2352 by 1568 pixels
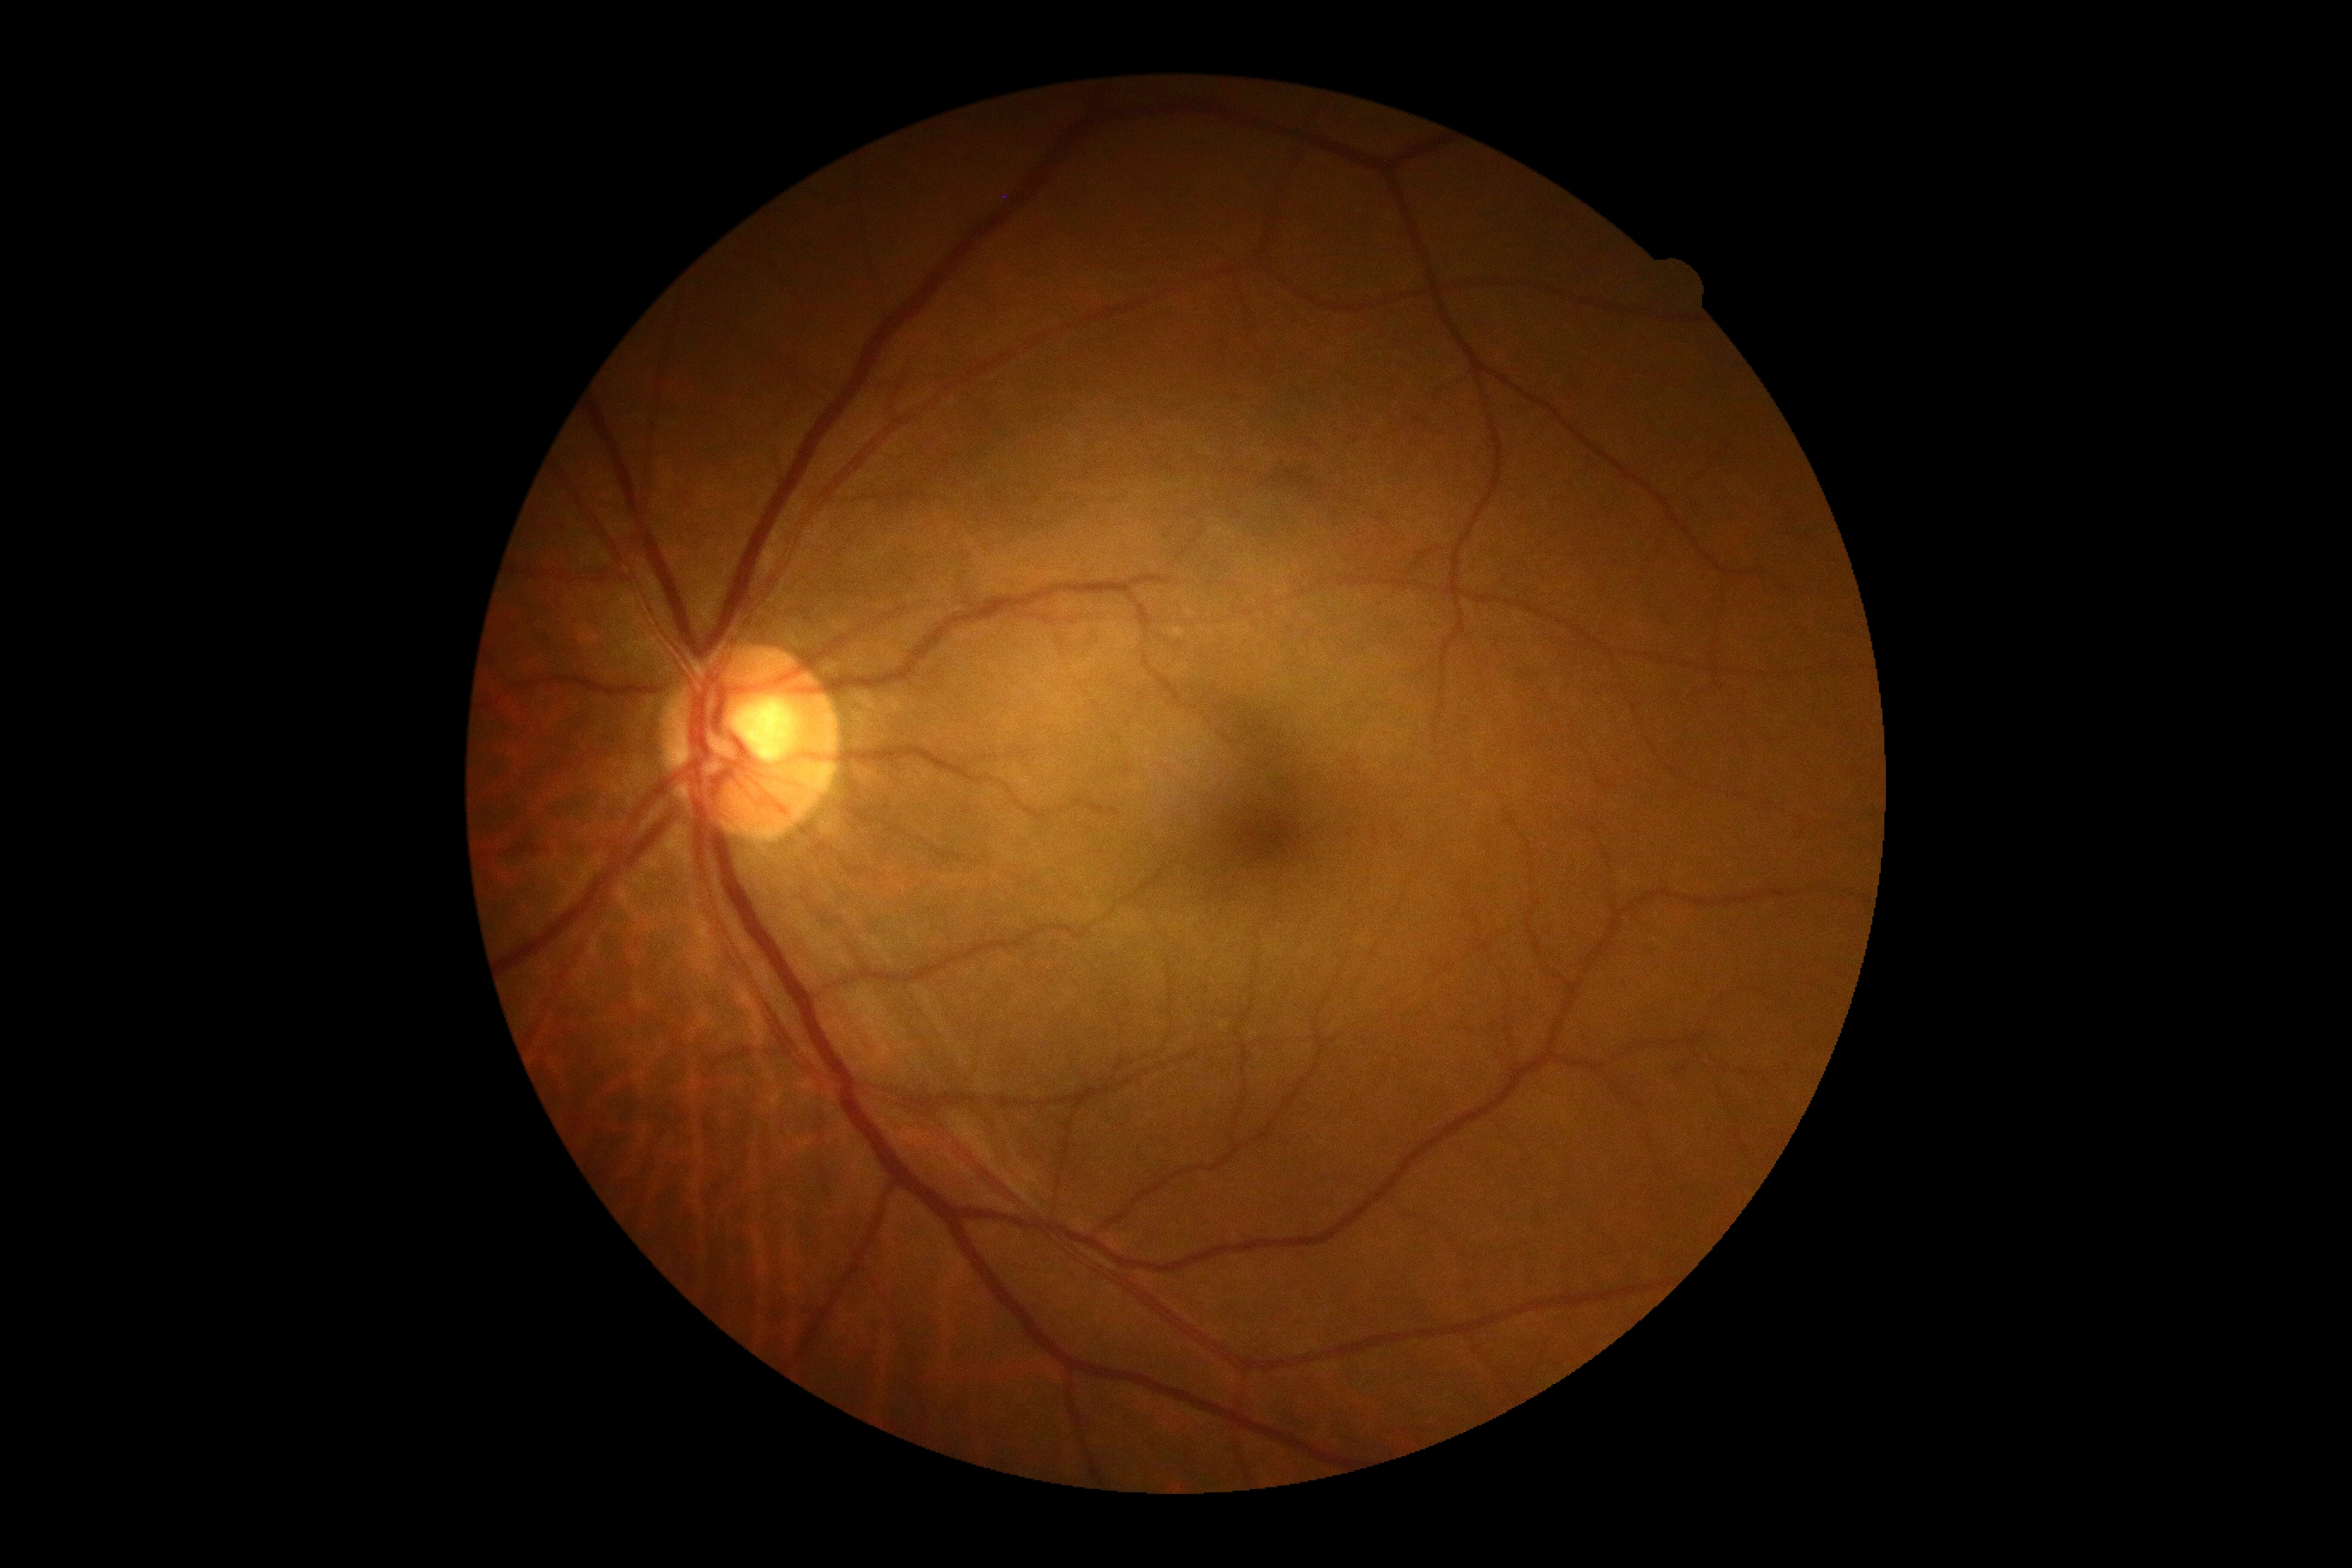 DR grade@0 (no apparent retinopathy); DR impression@no signs of DR.